2228x1652. Posterior pole view. Captured on a Topcon TRC-50DX fundus camera. Retinal fundus photograph
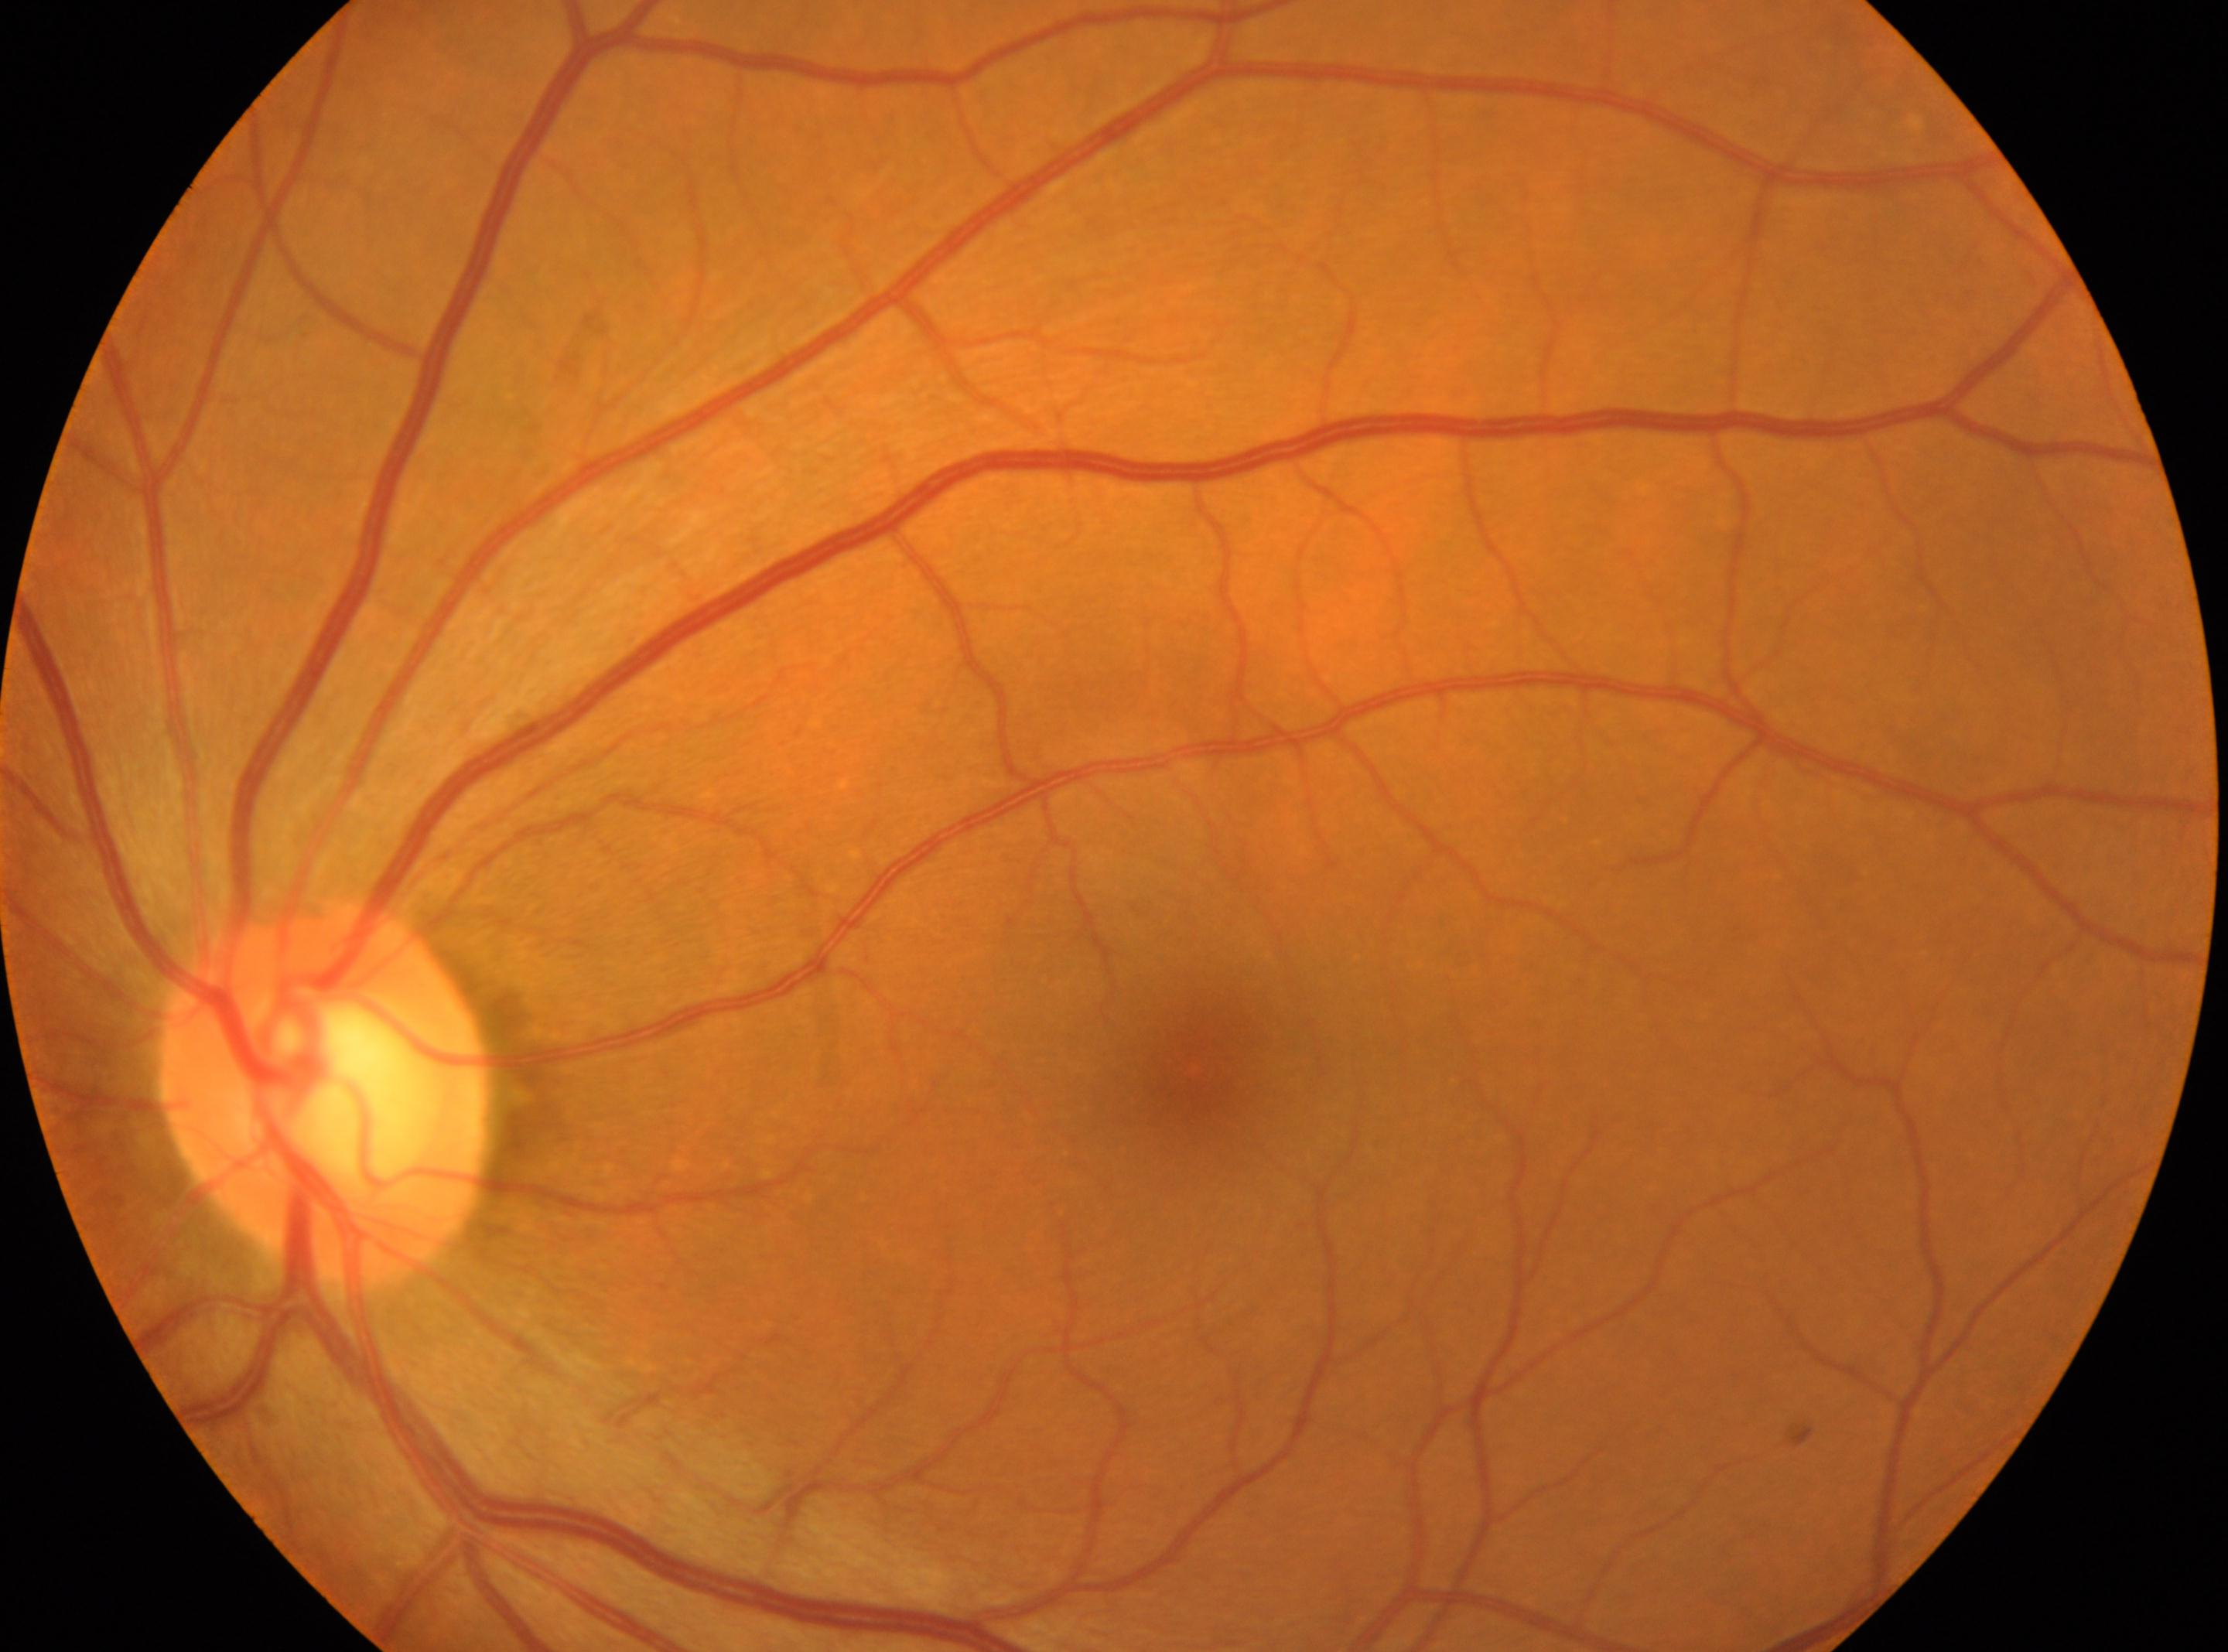
DR: grade 0 (no apparent retinopathy).
No diabetic retinopathy identified.
Imaged eye: oculus sinister.
Fovea: (1191,1070).
Optic disc center located at (320,1092).